Color fundus photograph. 2352x1568: 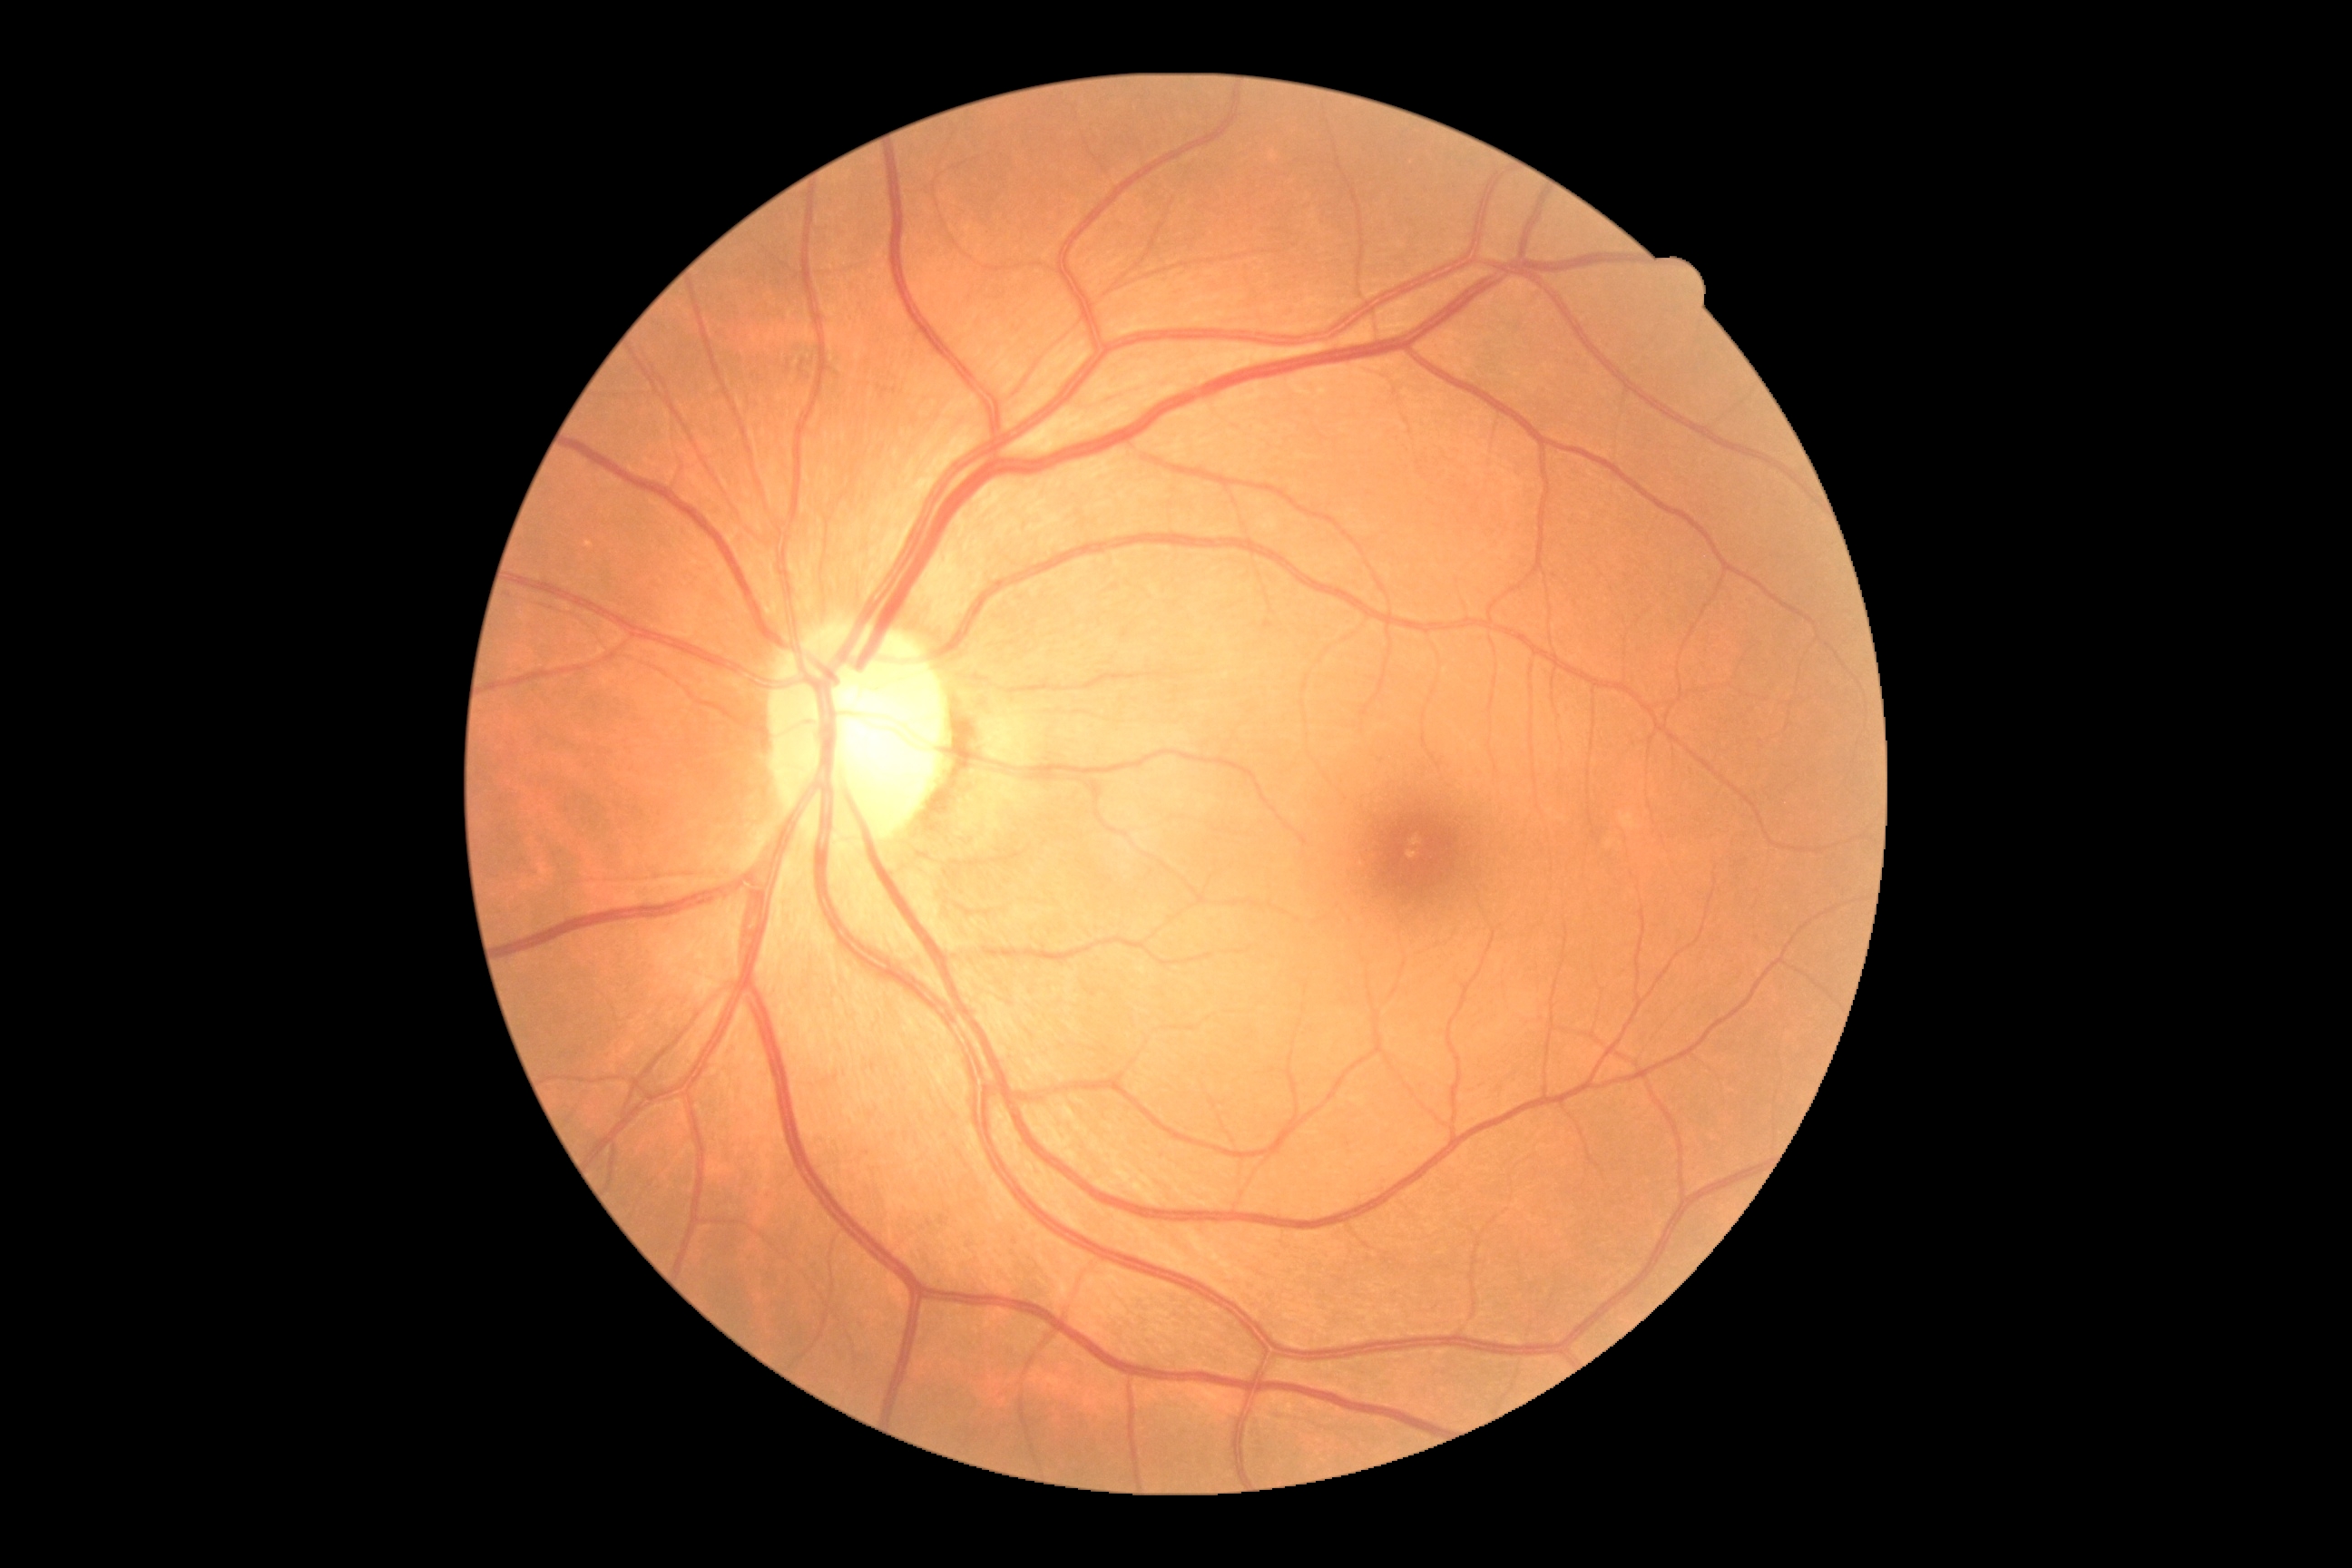

{
  "dr_impression": "no signs of DR",
  "dr_grade": "grade 0 (no apparent retinopathy)"
}